DR severity per modified Davis staging; NIDEK AFC-230 fundus camera:
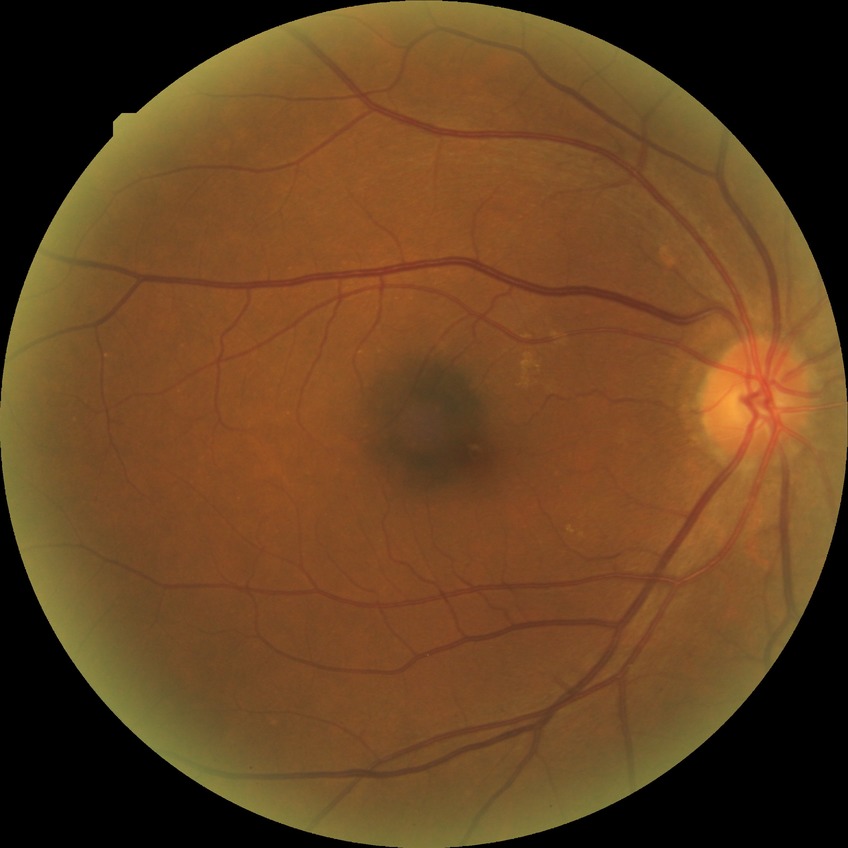
DR severity is SDR.